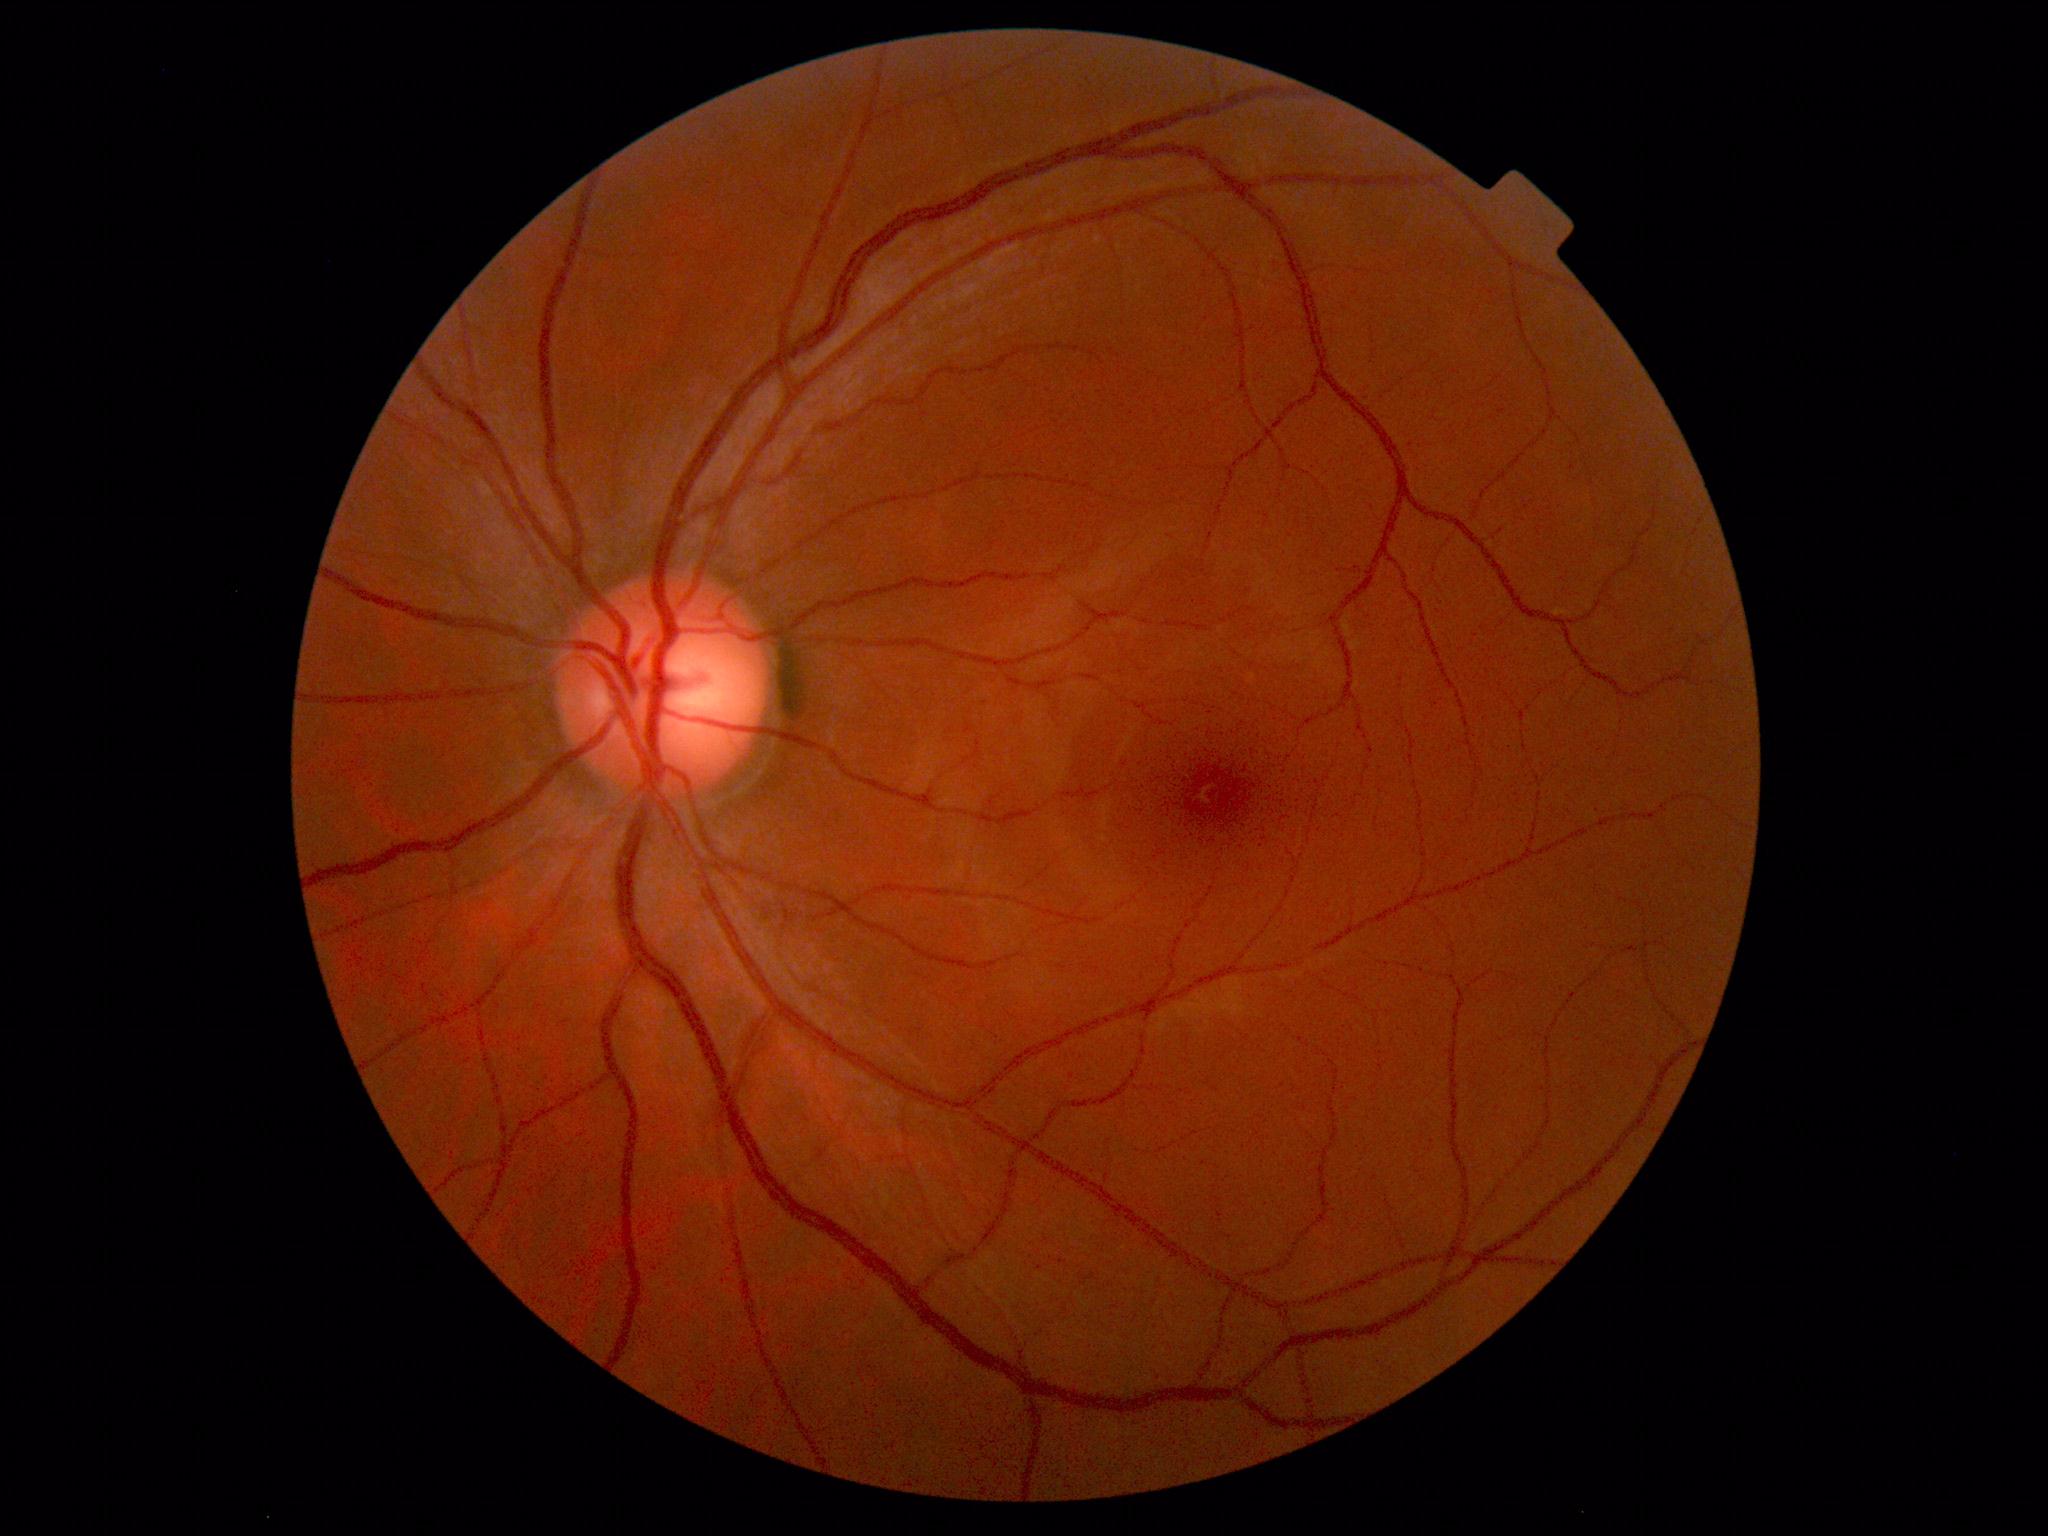 Diagnosis: normal.